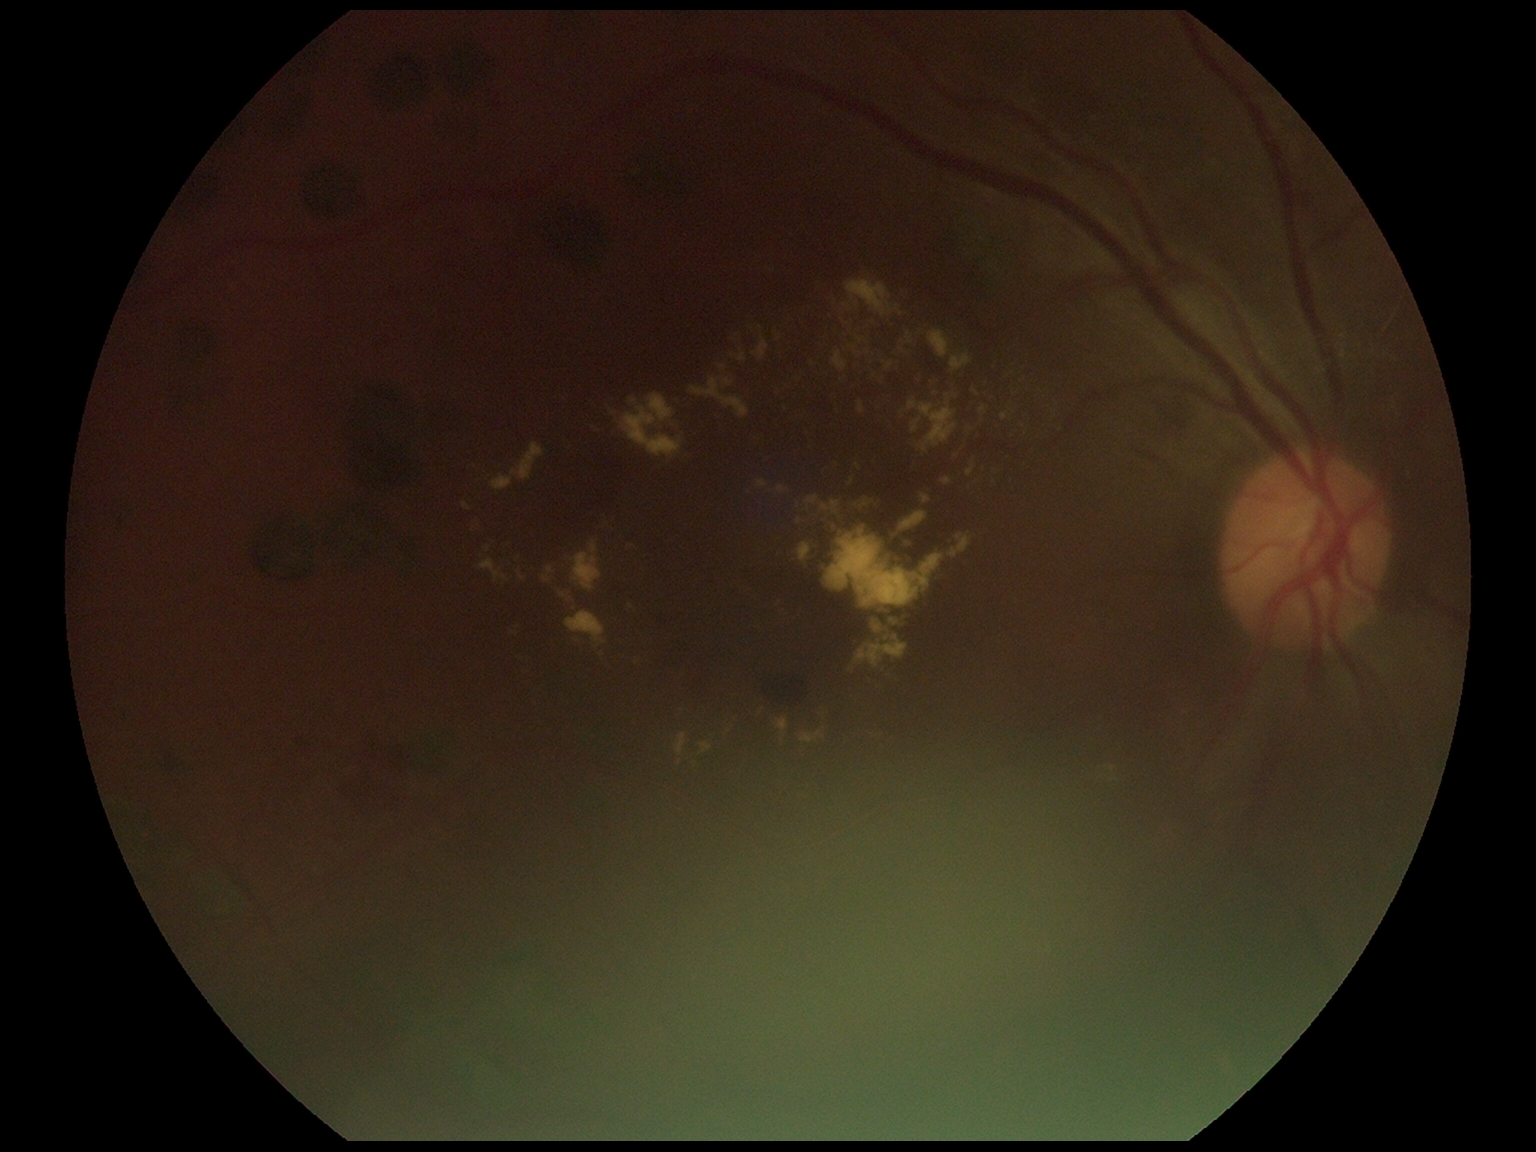 Diabetic retinopathy (DR): 2/4.